Phoenix ICON wide-field infant fundus image · 100° field of view (Phoenix ICON).
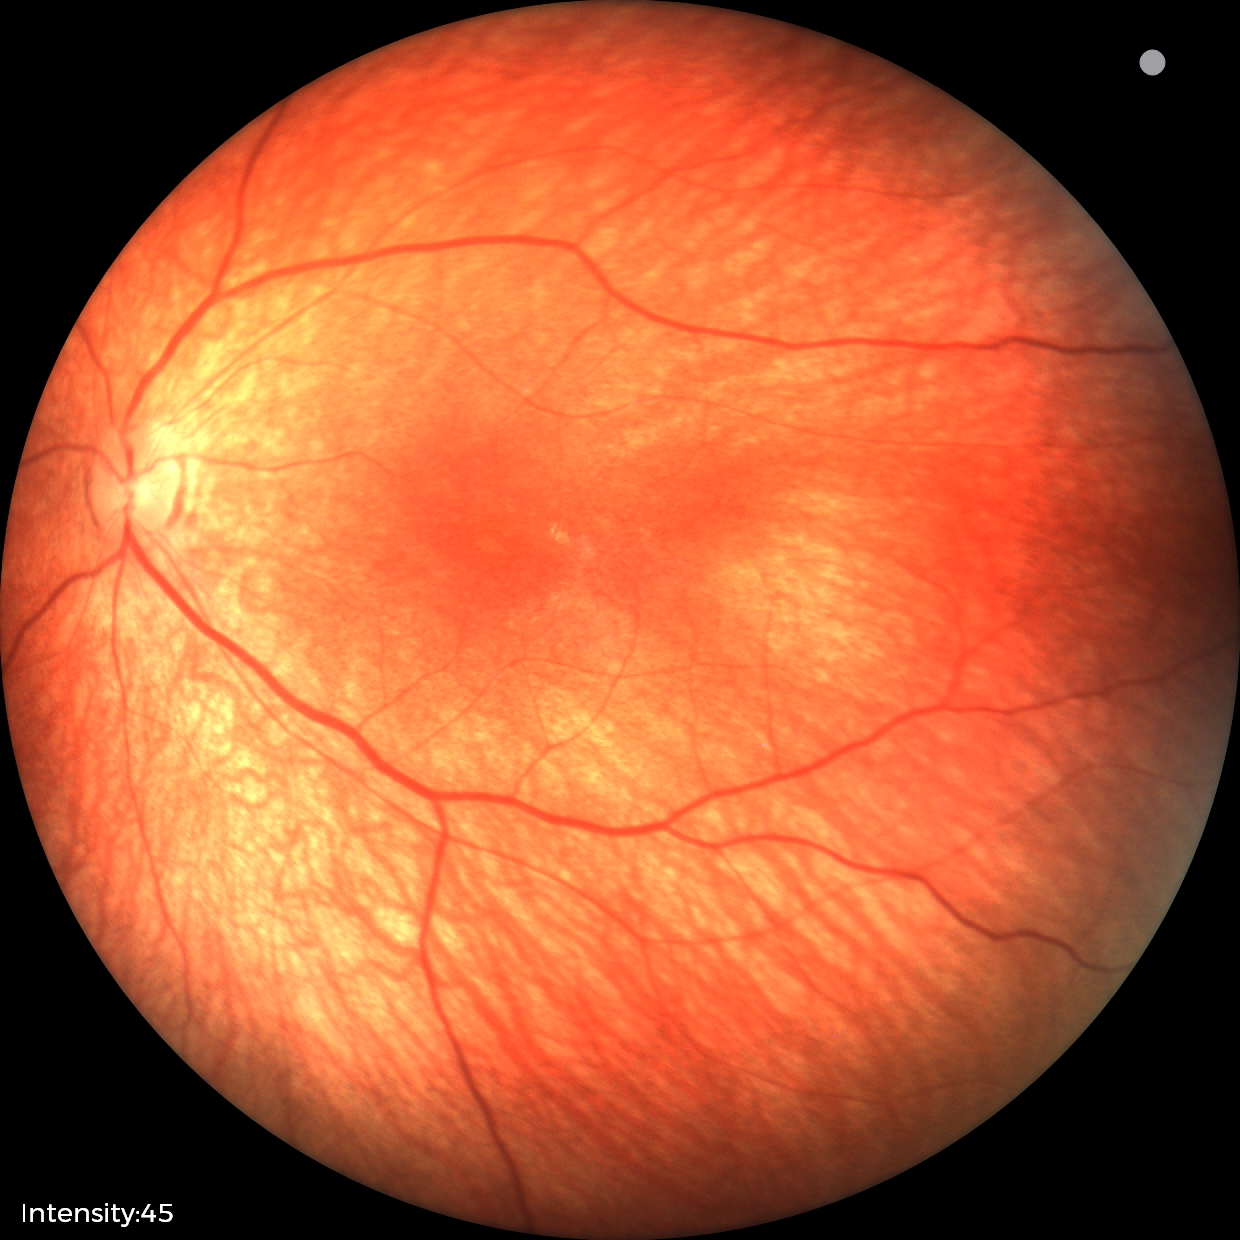

Finding = physiological appearance.